Wide-field fundus photograph from neonatal ROP screening — 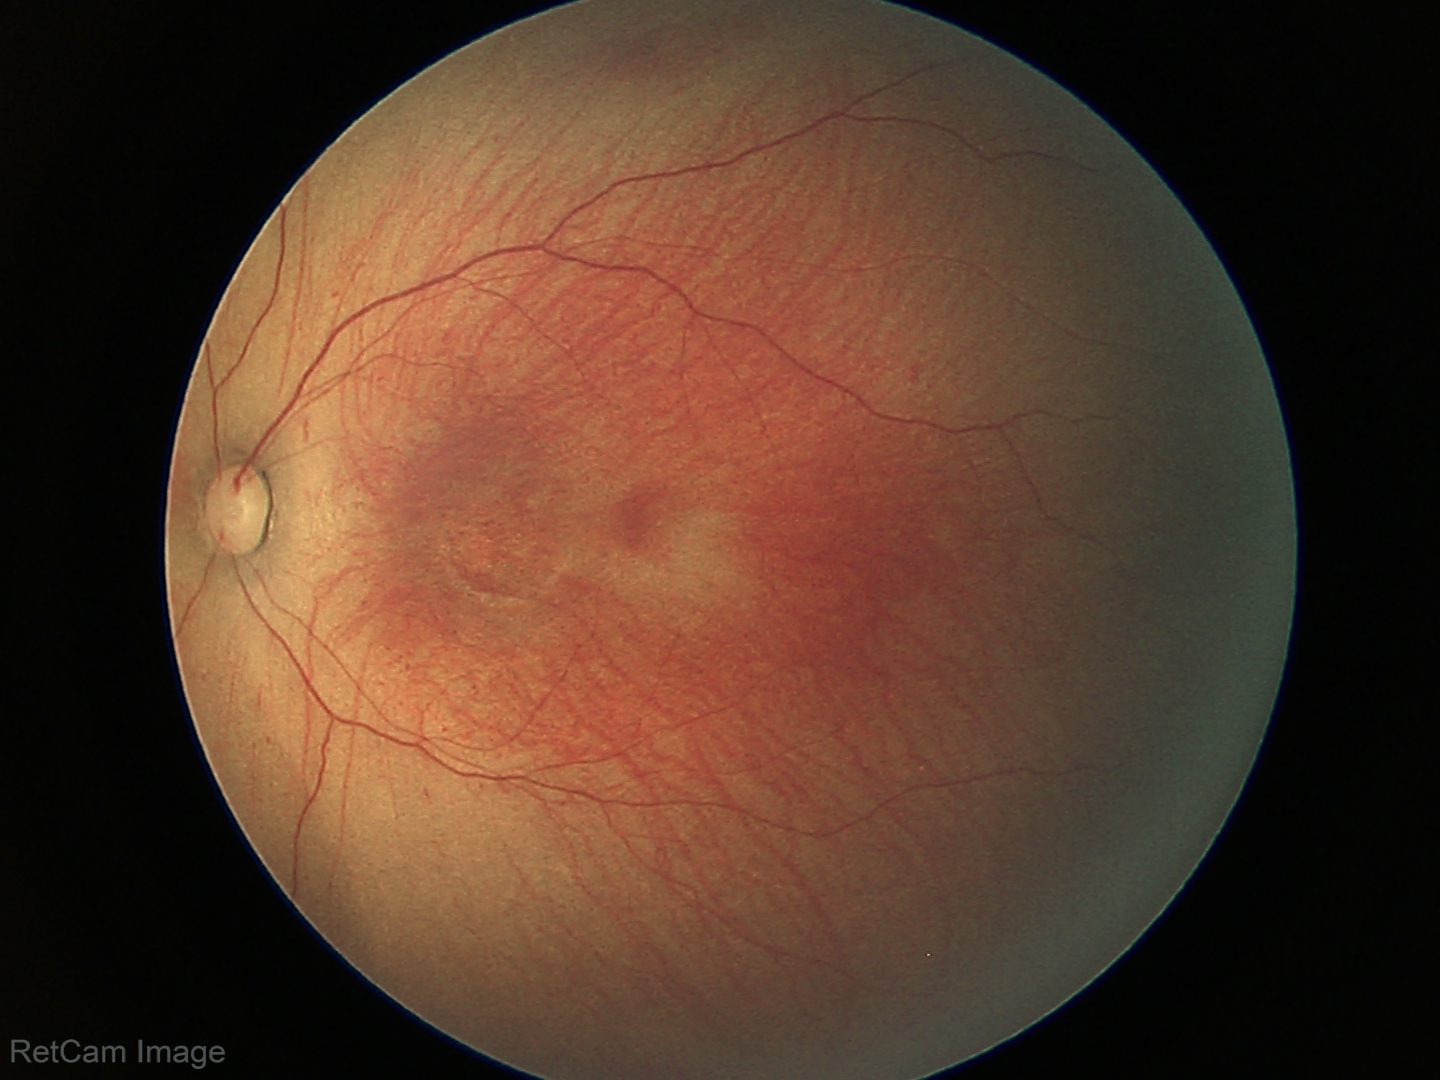 Impression: ROP stage 1 | no plus disease — posterior pole vessels without abnormal dilation or tortuosity.